Captured with the Phoenix ICON (100° field of view); wide-field fundus photograph from neonatal ROP screening; 1240 by 1240 pixels — 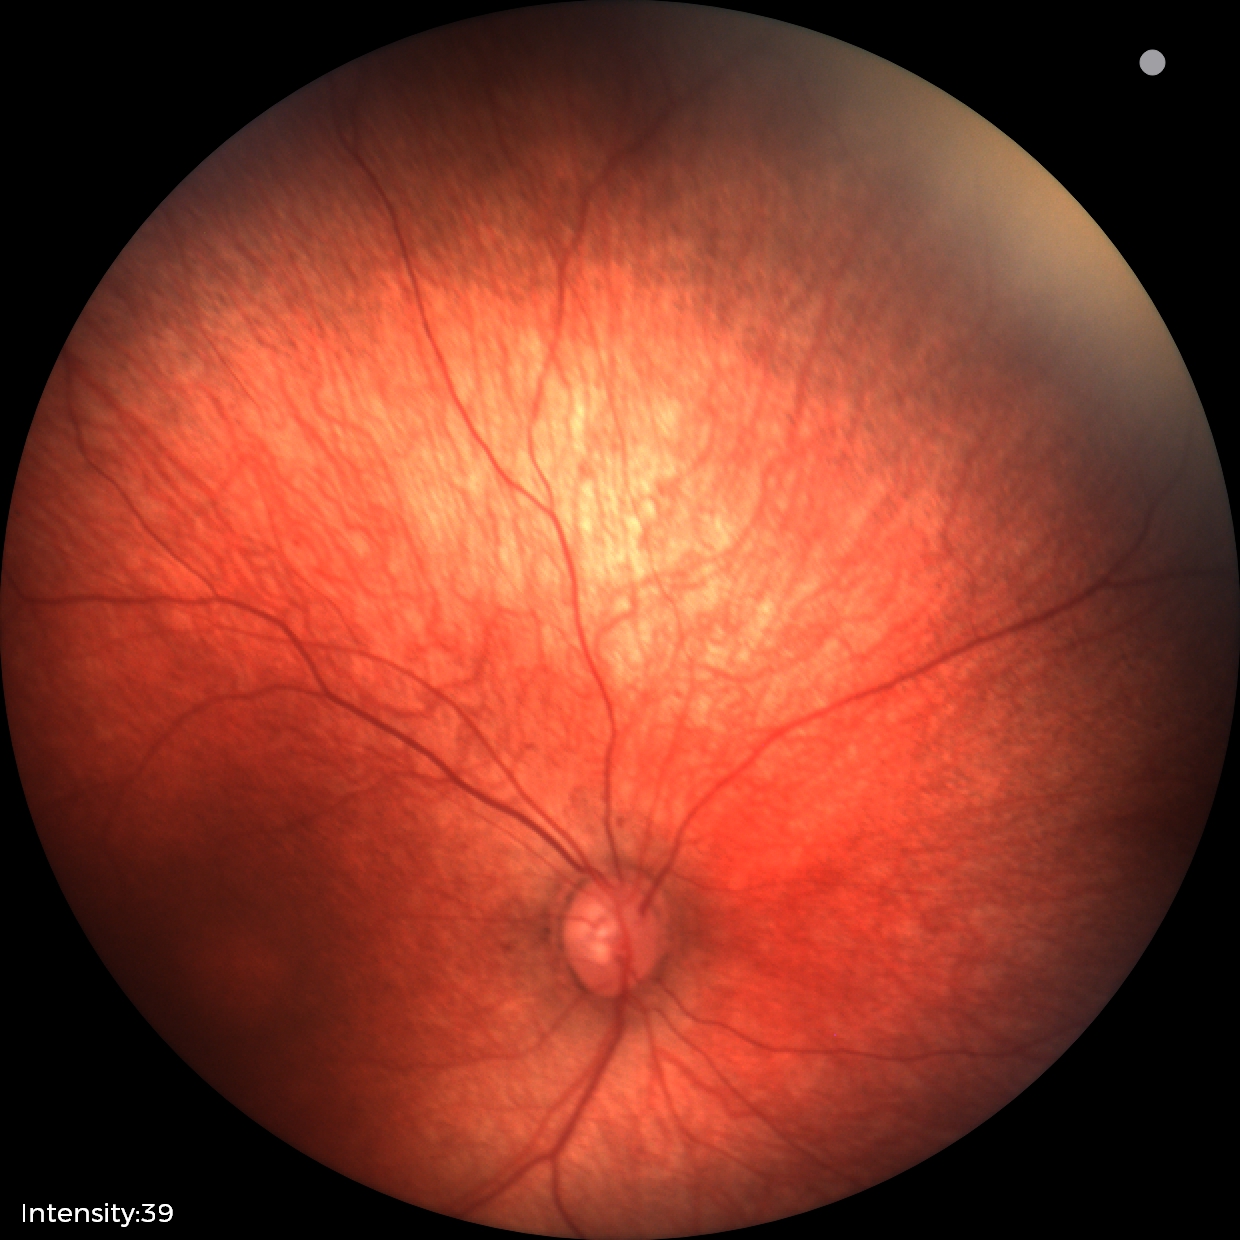

Q: What is the screening diagnosis?
A: normal fundus examination